1932x1932, color fundus photograph: 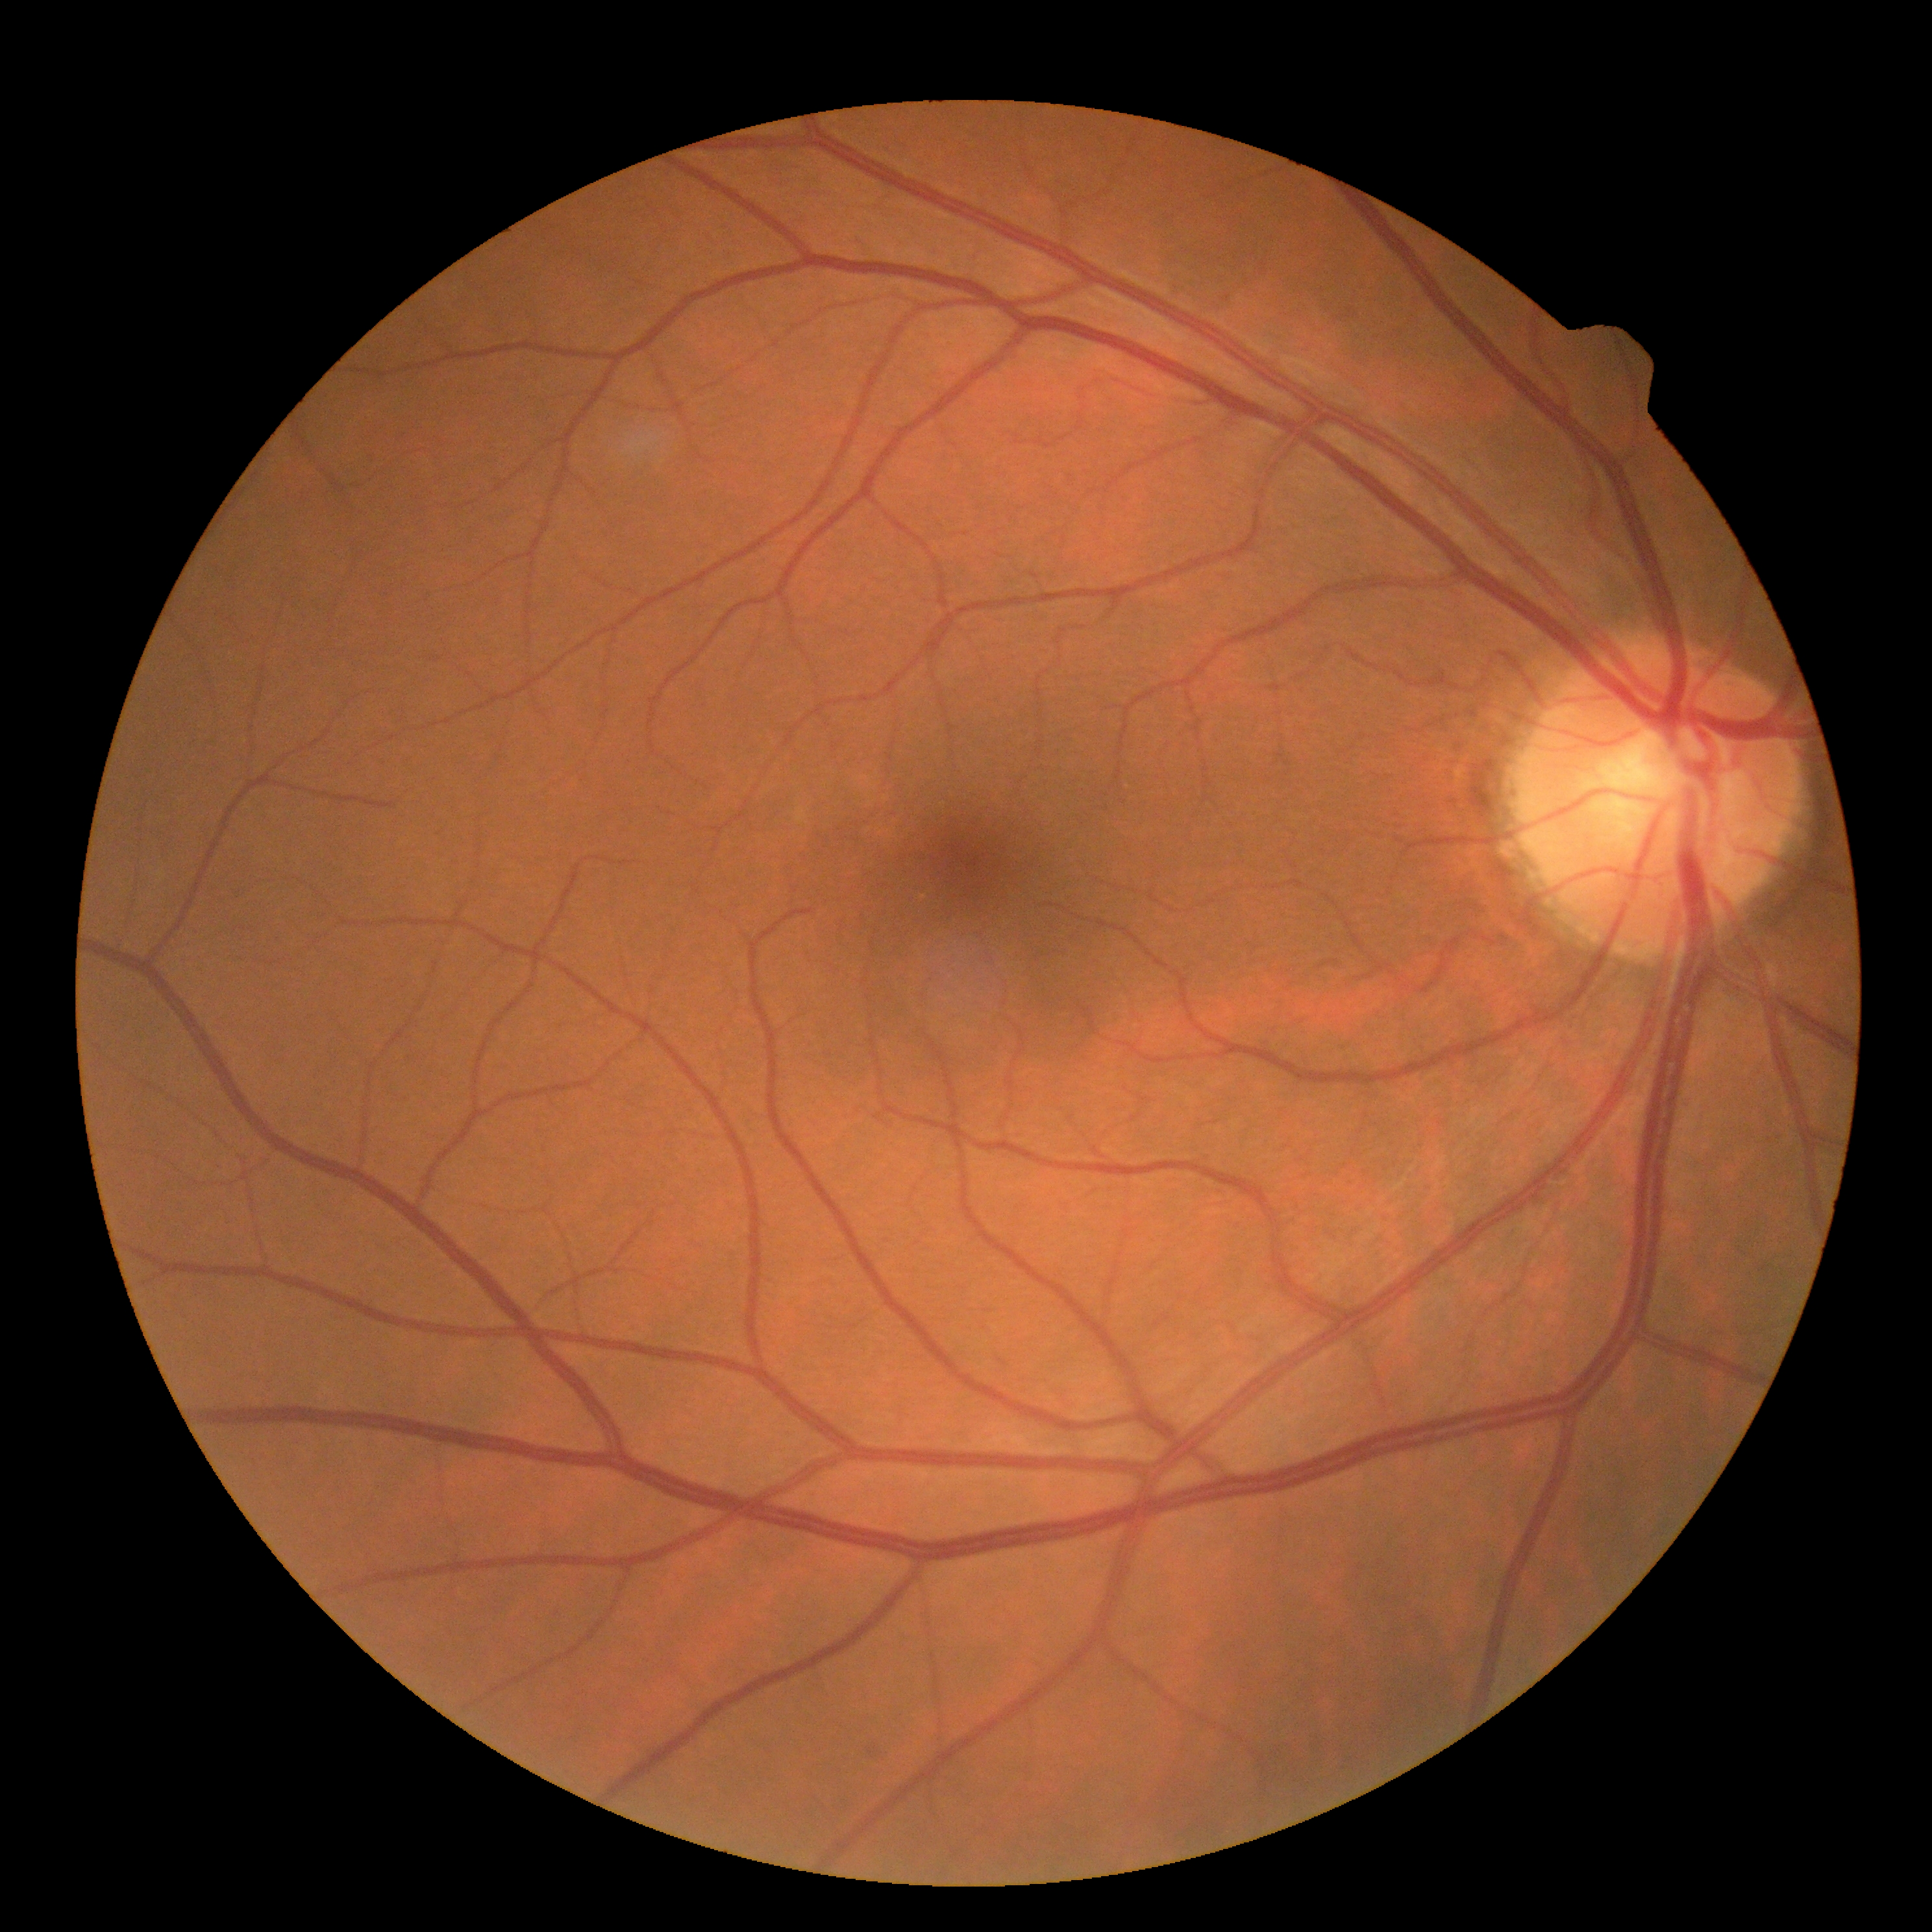

retinopathy=0/4, DR impression=no apparent DR.